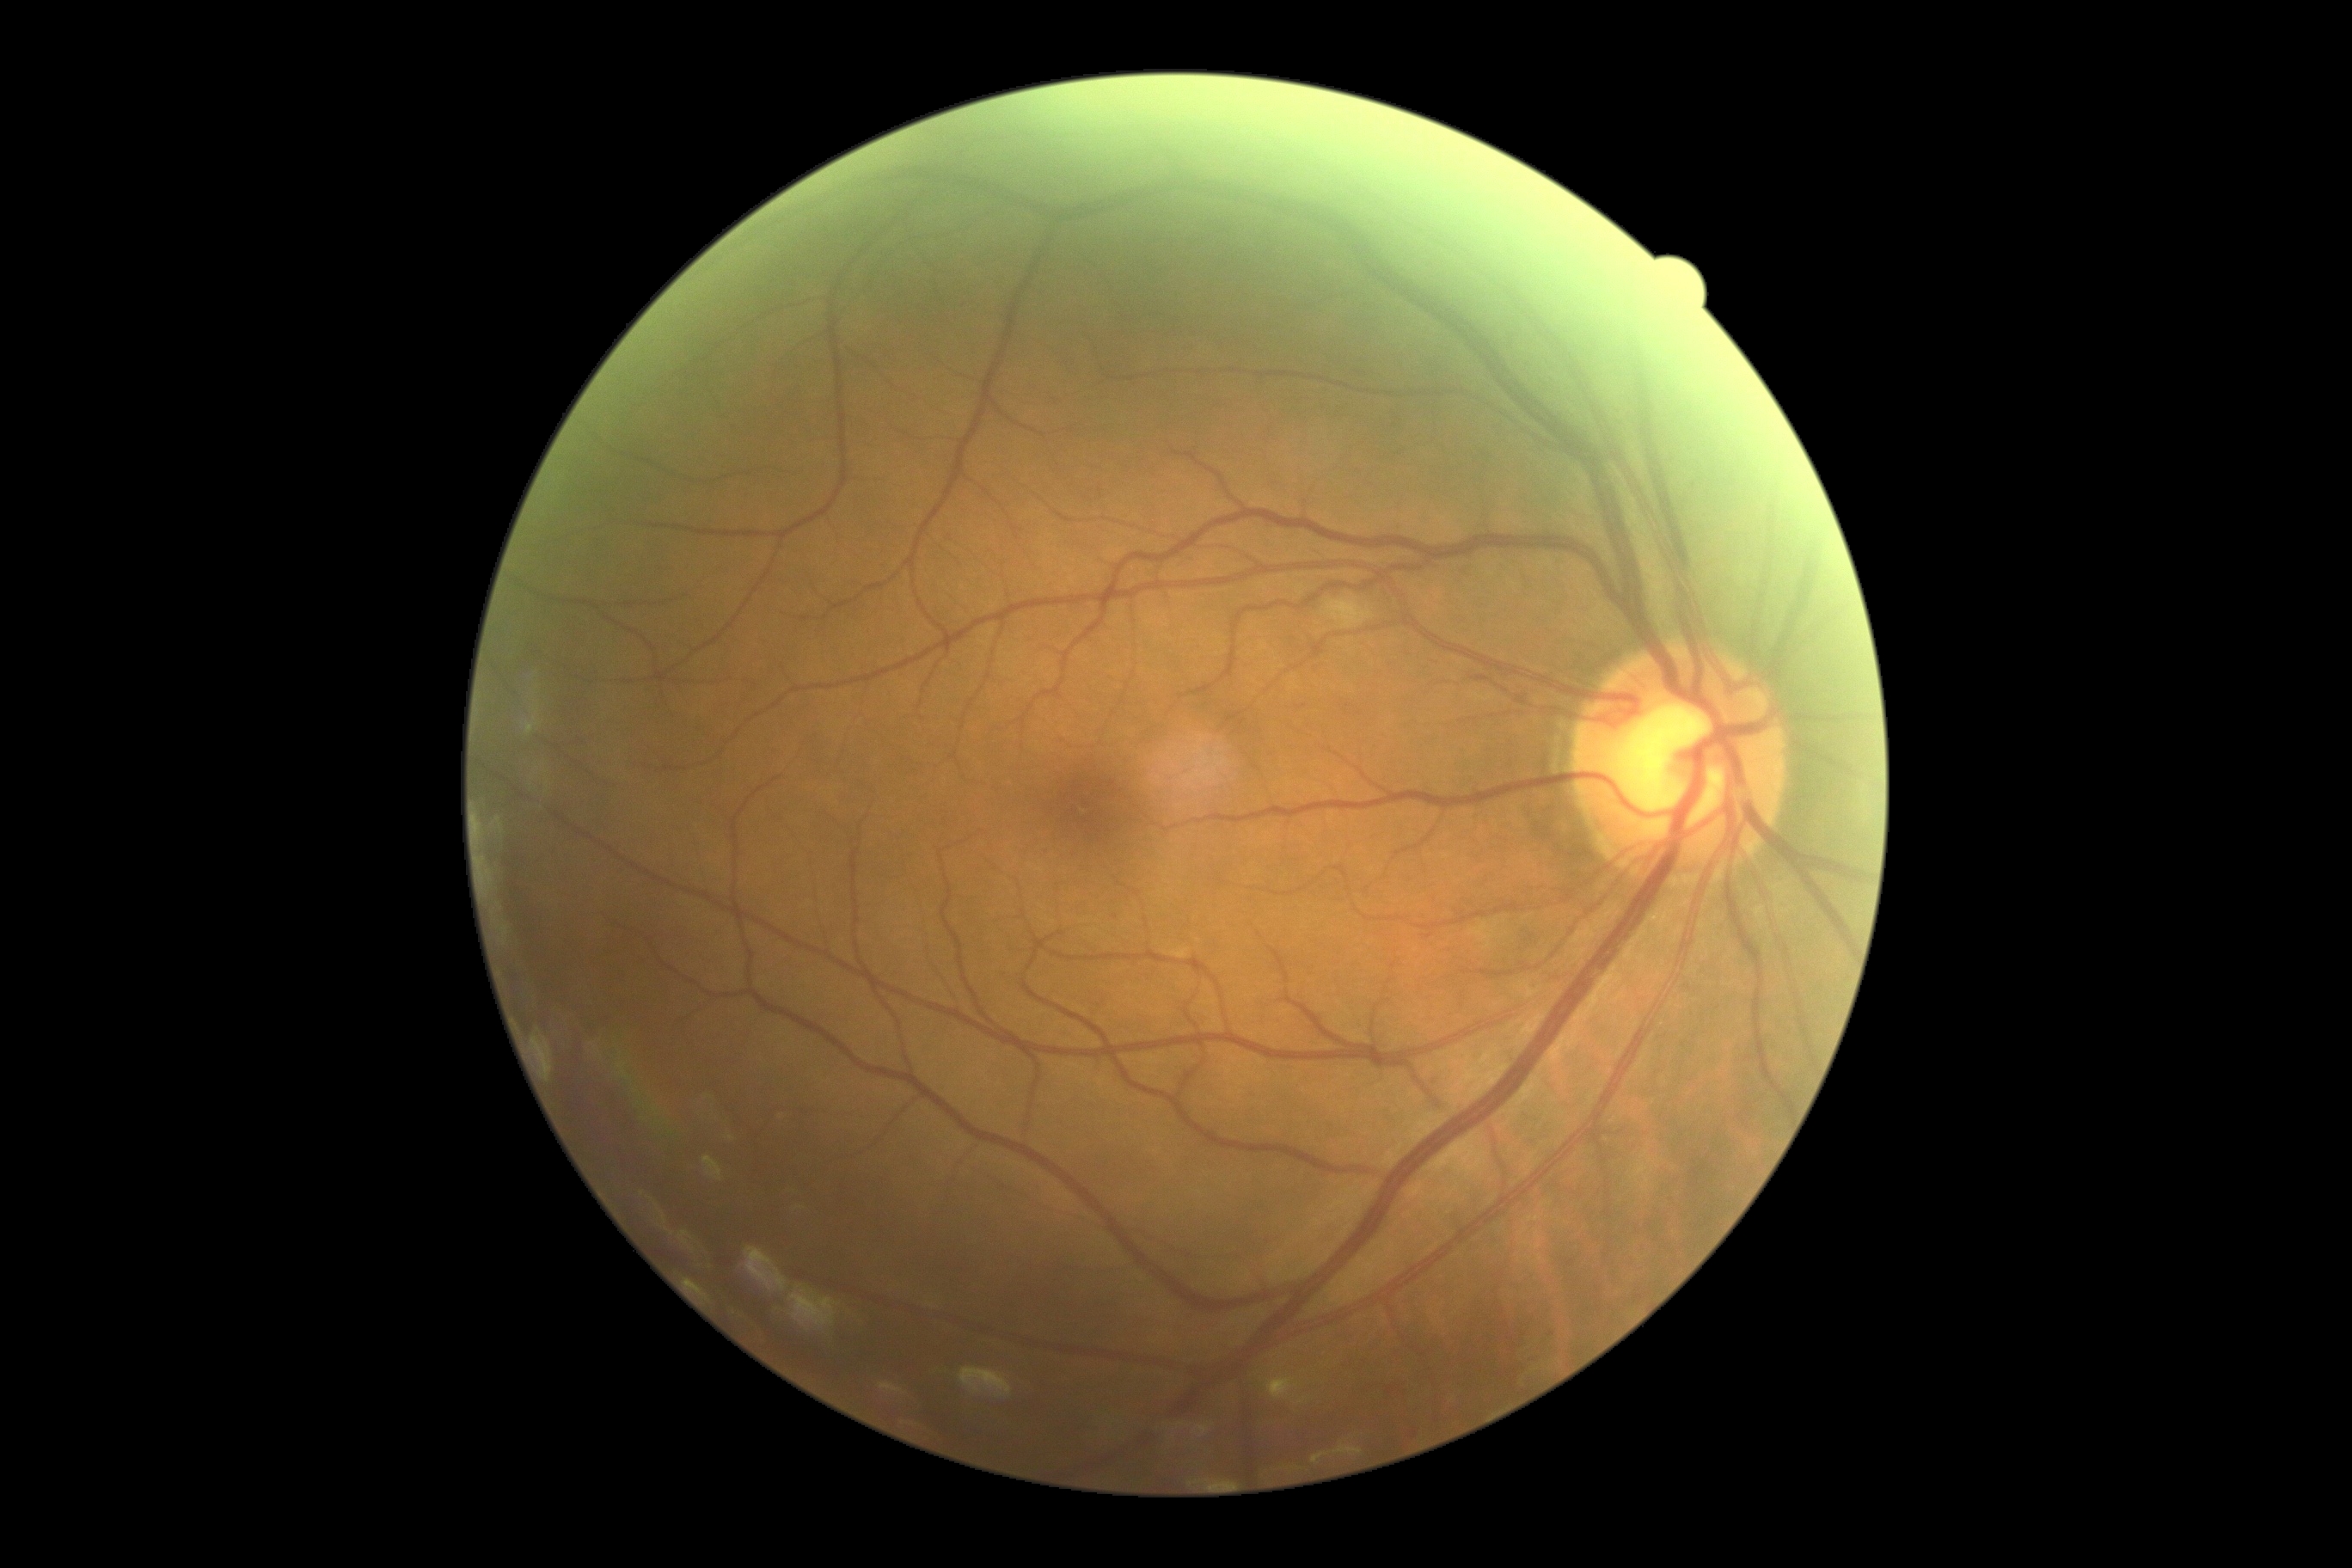
DR stage is 2 — more than just microaneurysms but less than severe NPDR. The retinopathy is classified as non-proliferative diabetic retinopathy.